1380 x 1382 pixels, FOV: 45 degrees — 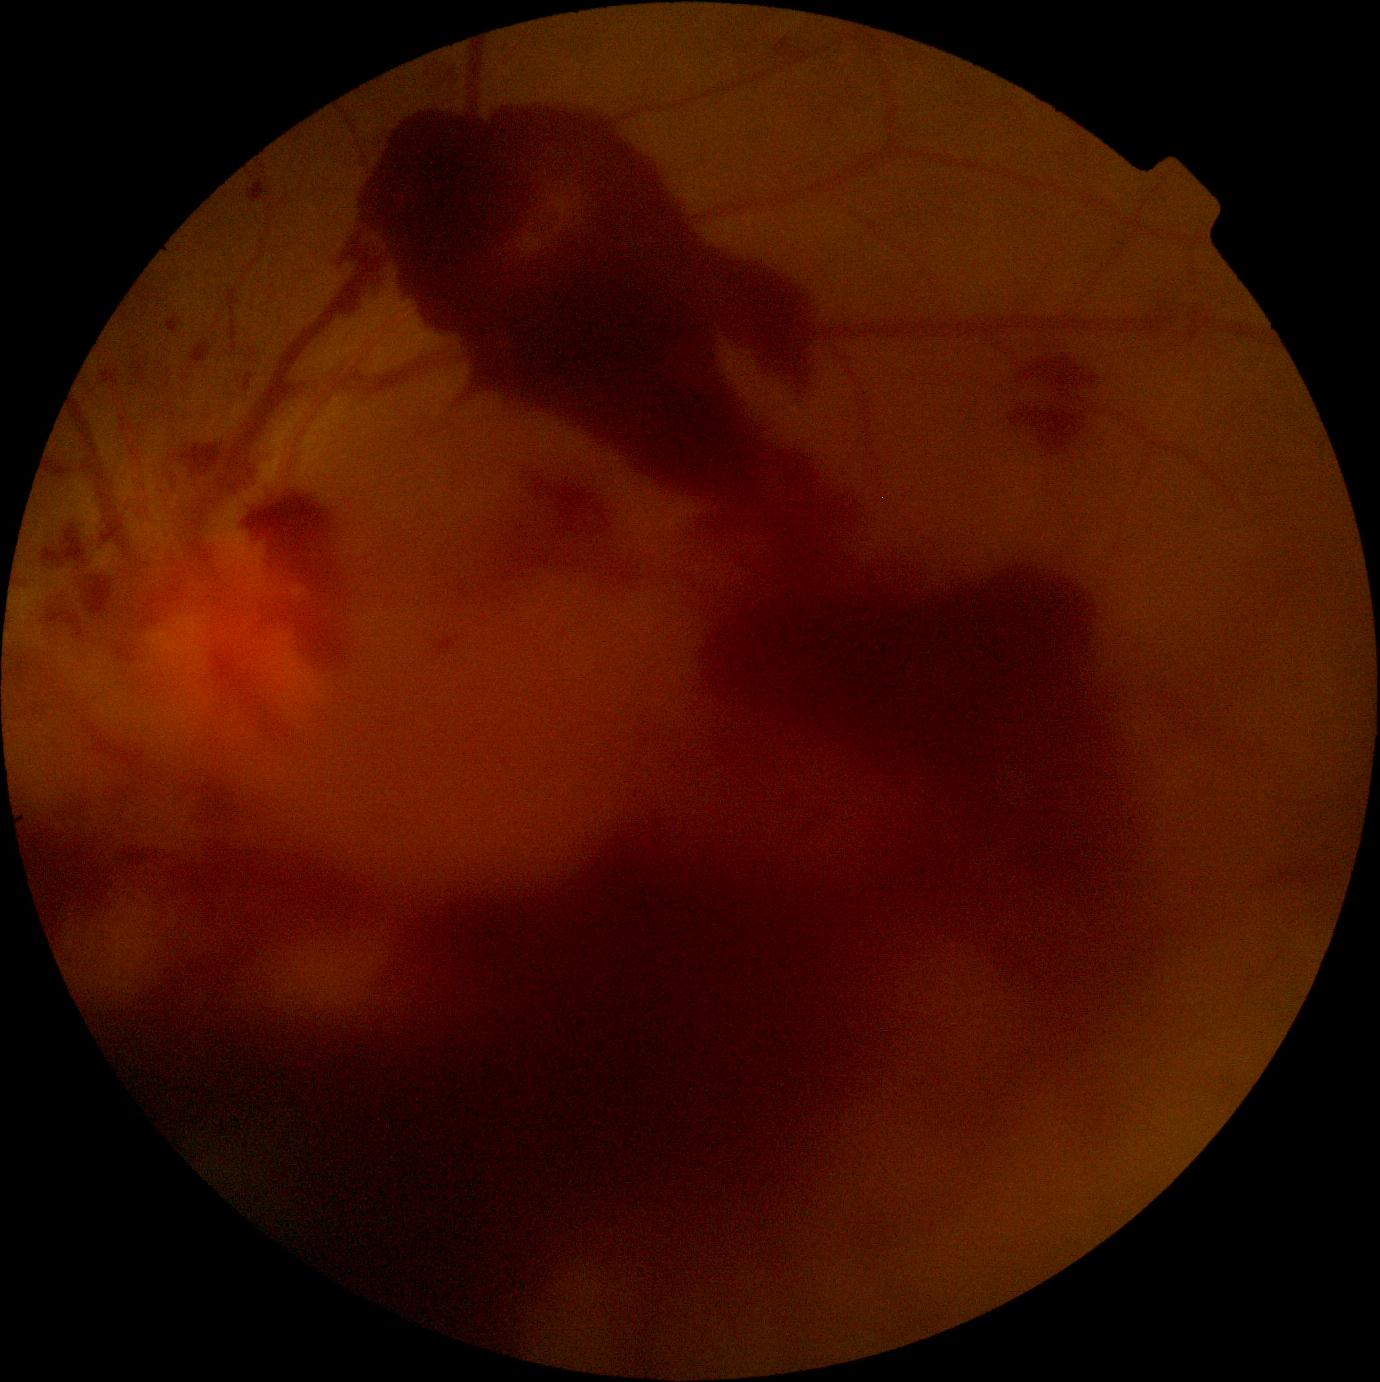 dr_grade: 4/4